Fundus photograph cropped around the optic nerve head — 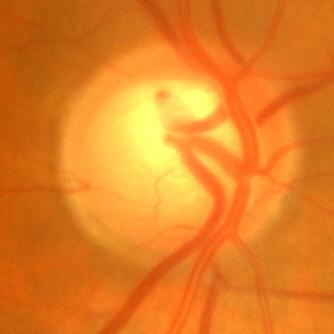

Q: Glaucoma assessment?
A: No — no glaucomatous changes.